Fundus photo, NIDEK AFC-230, modified Davis classification
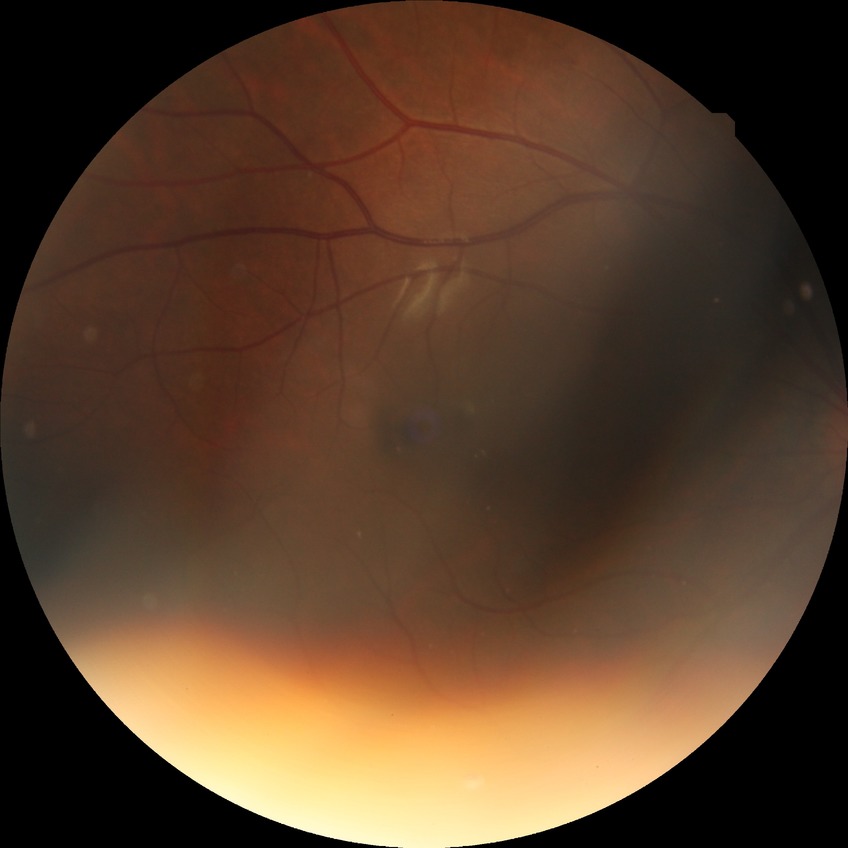
Davis stage is NDR.